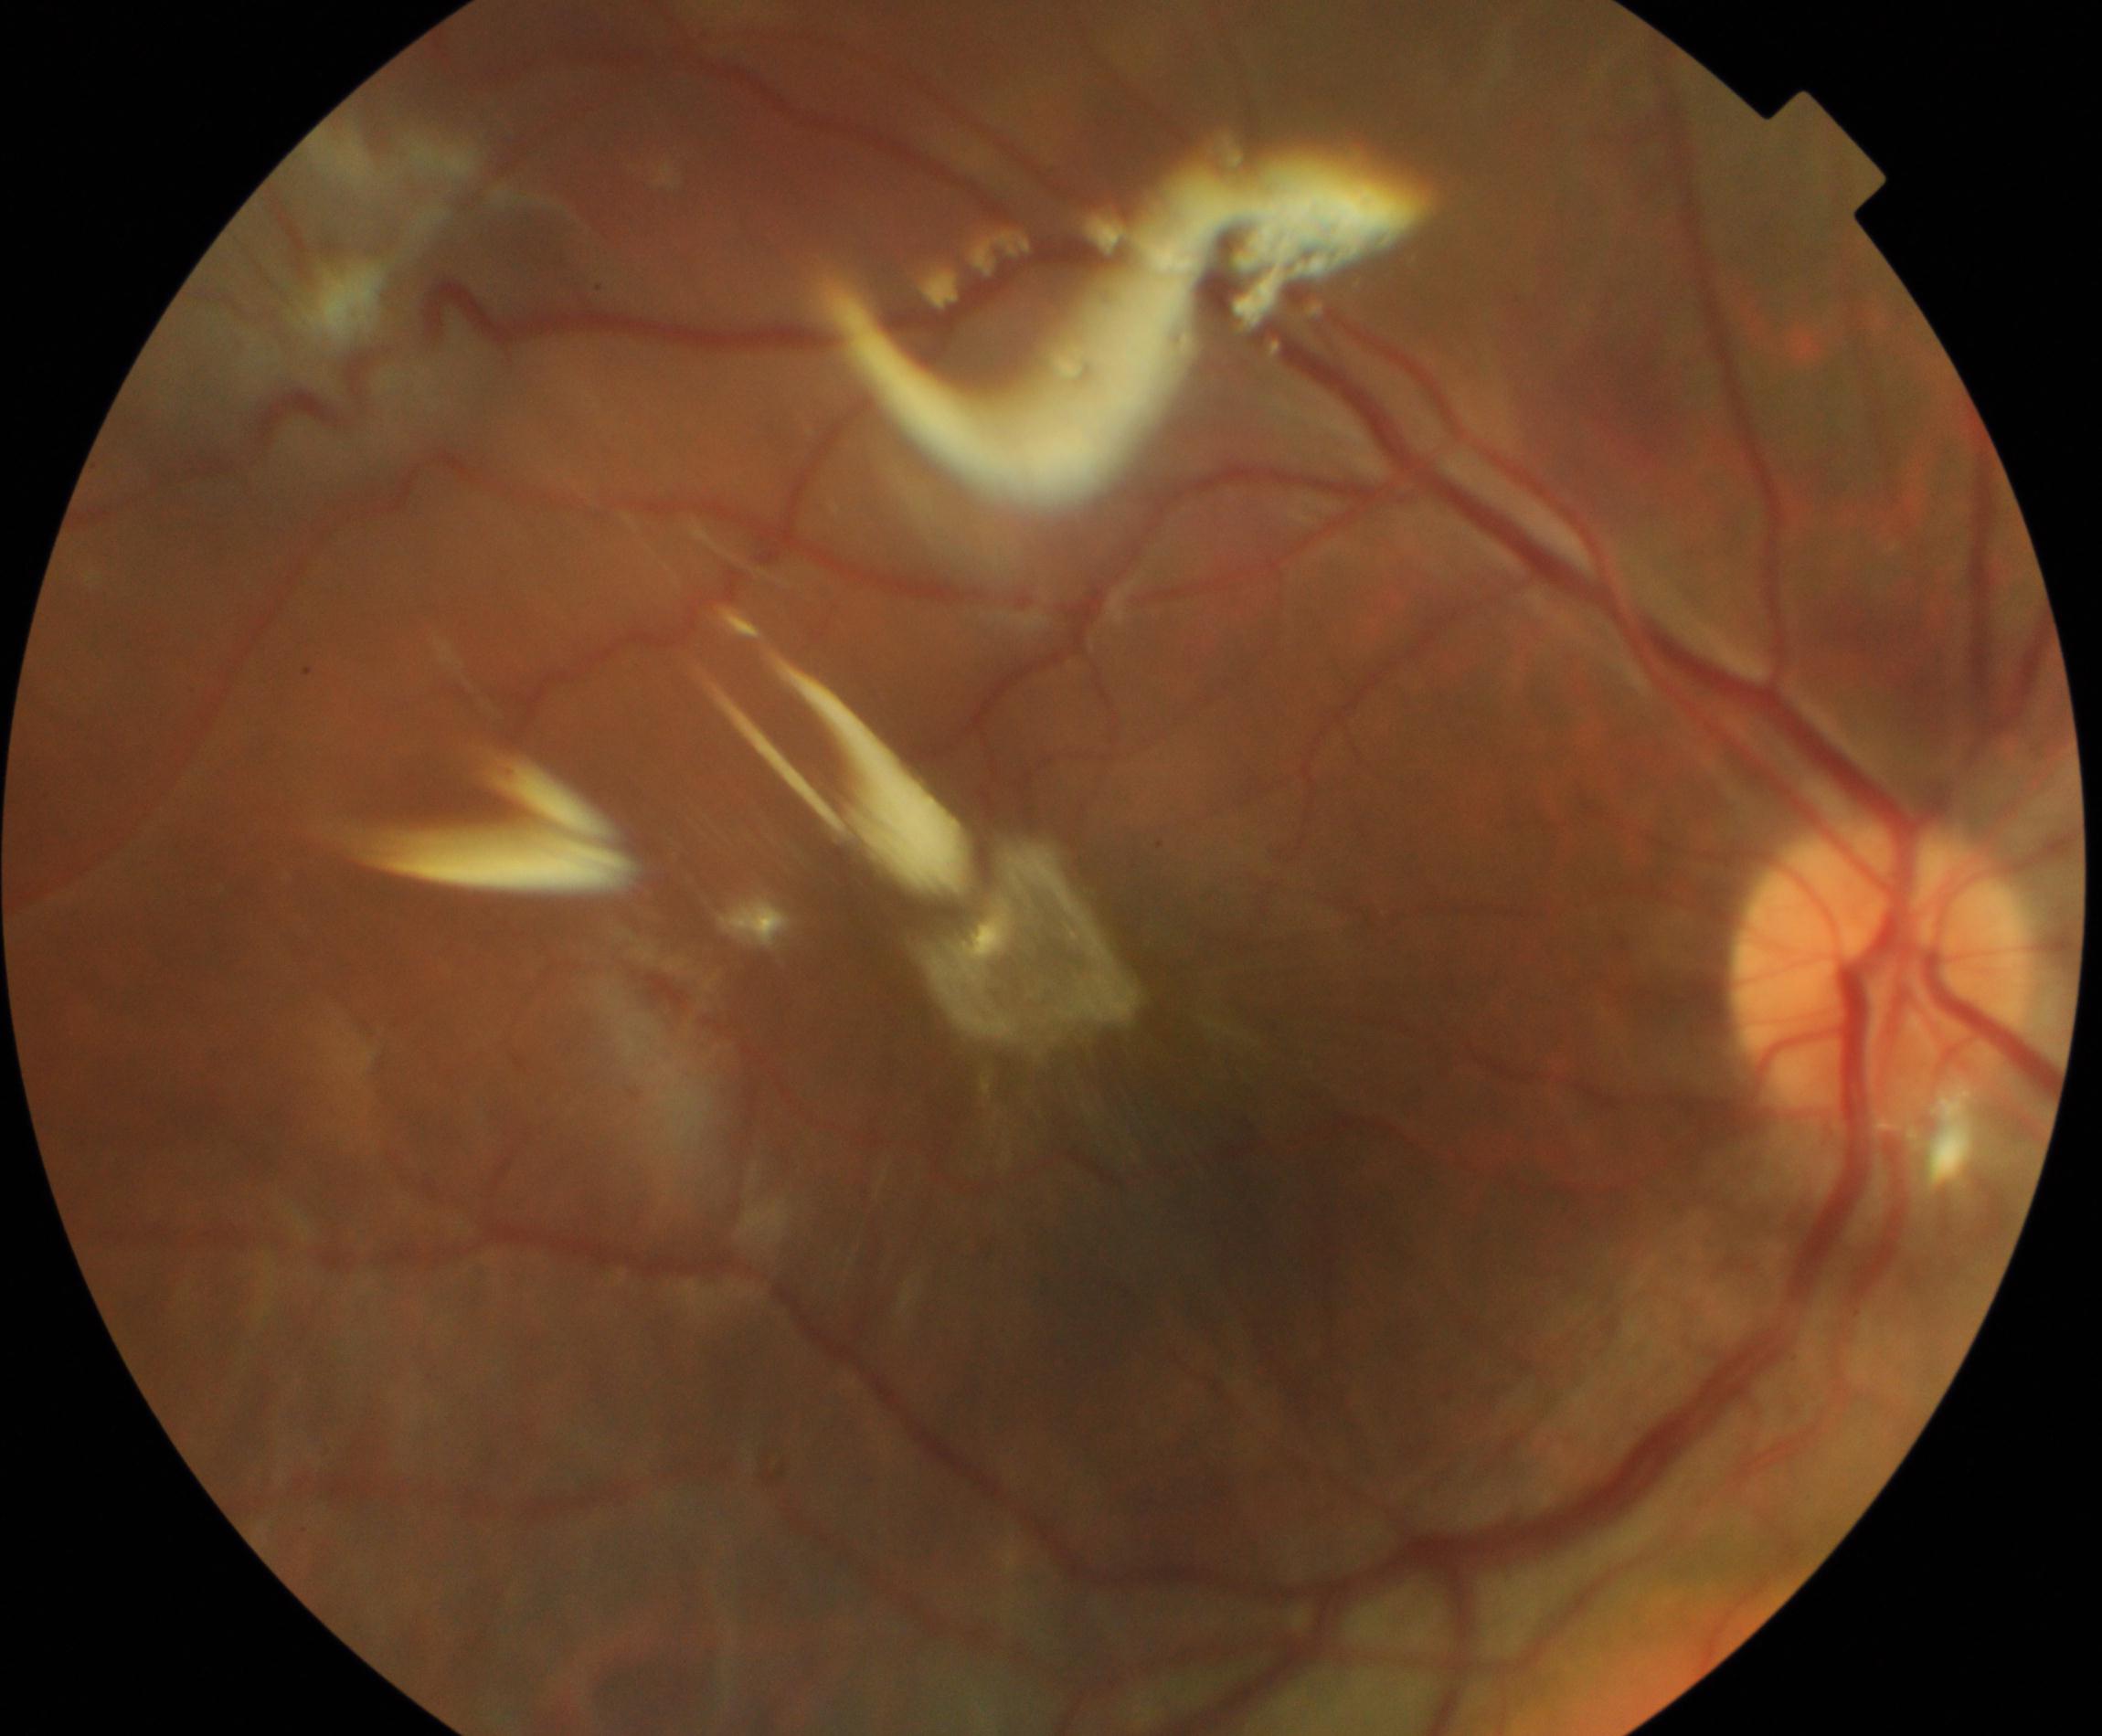 Findings: silicone oil in the eye.